2352x1568px, 45° FOV:
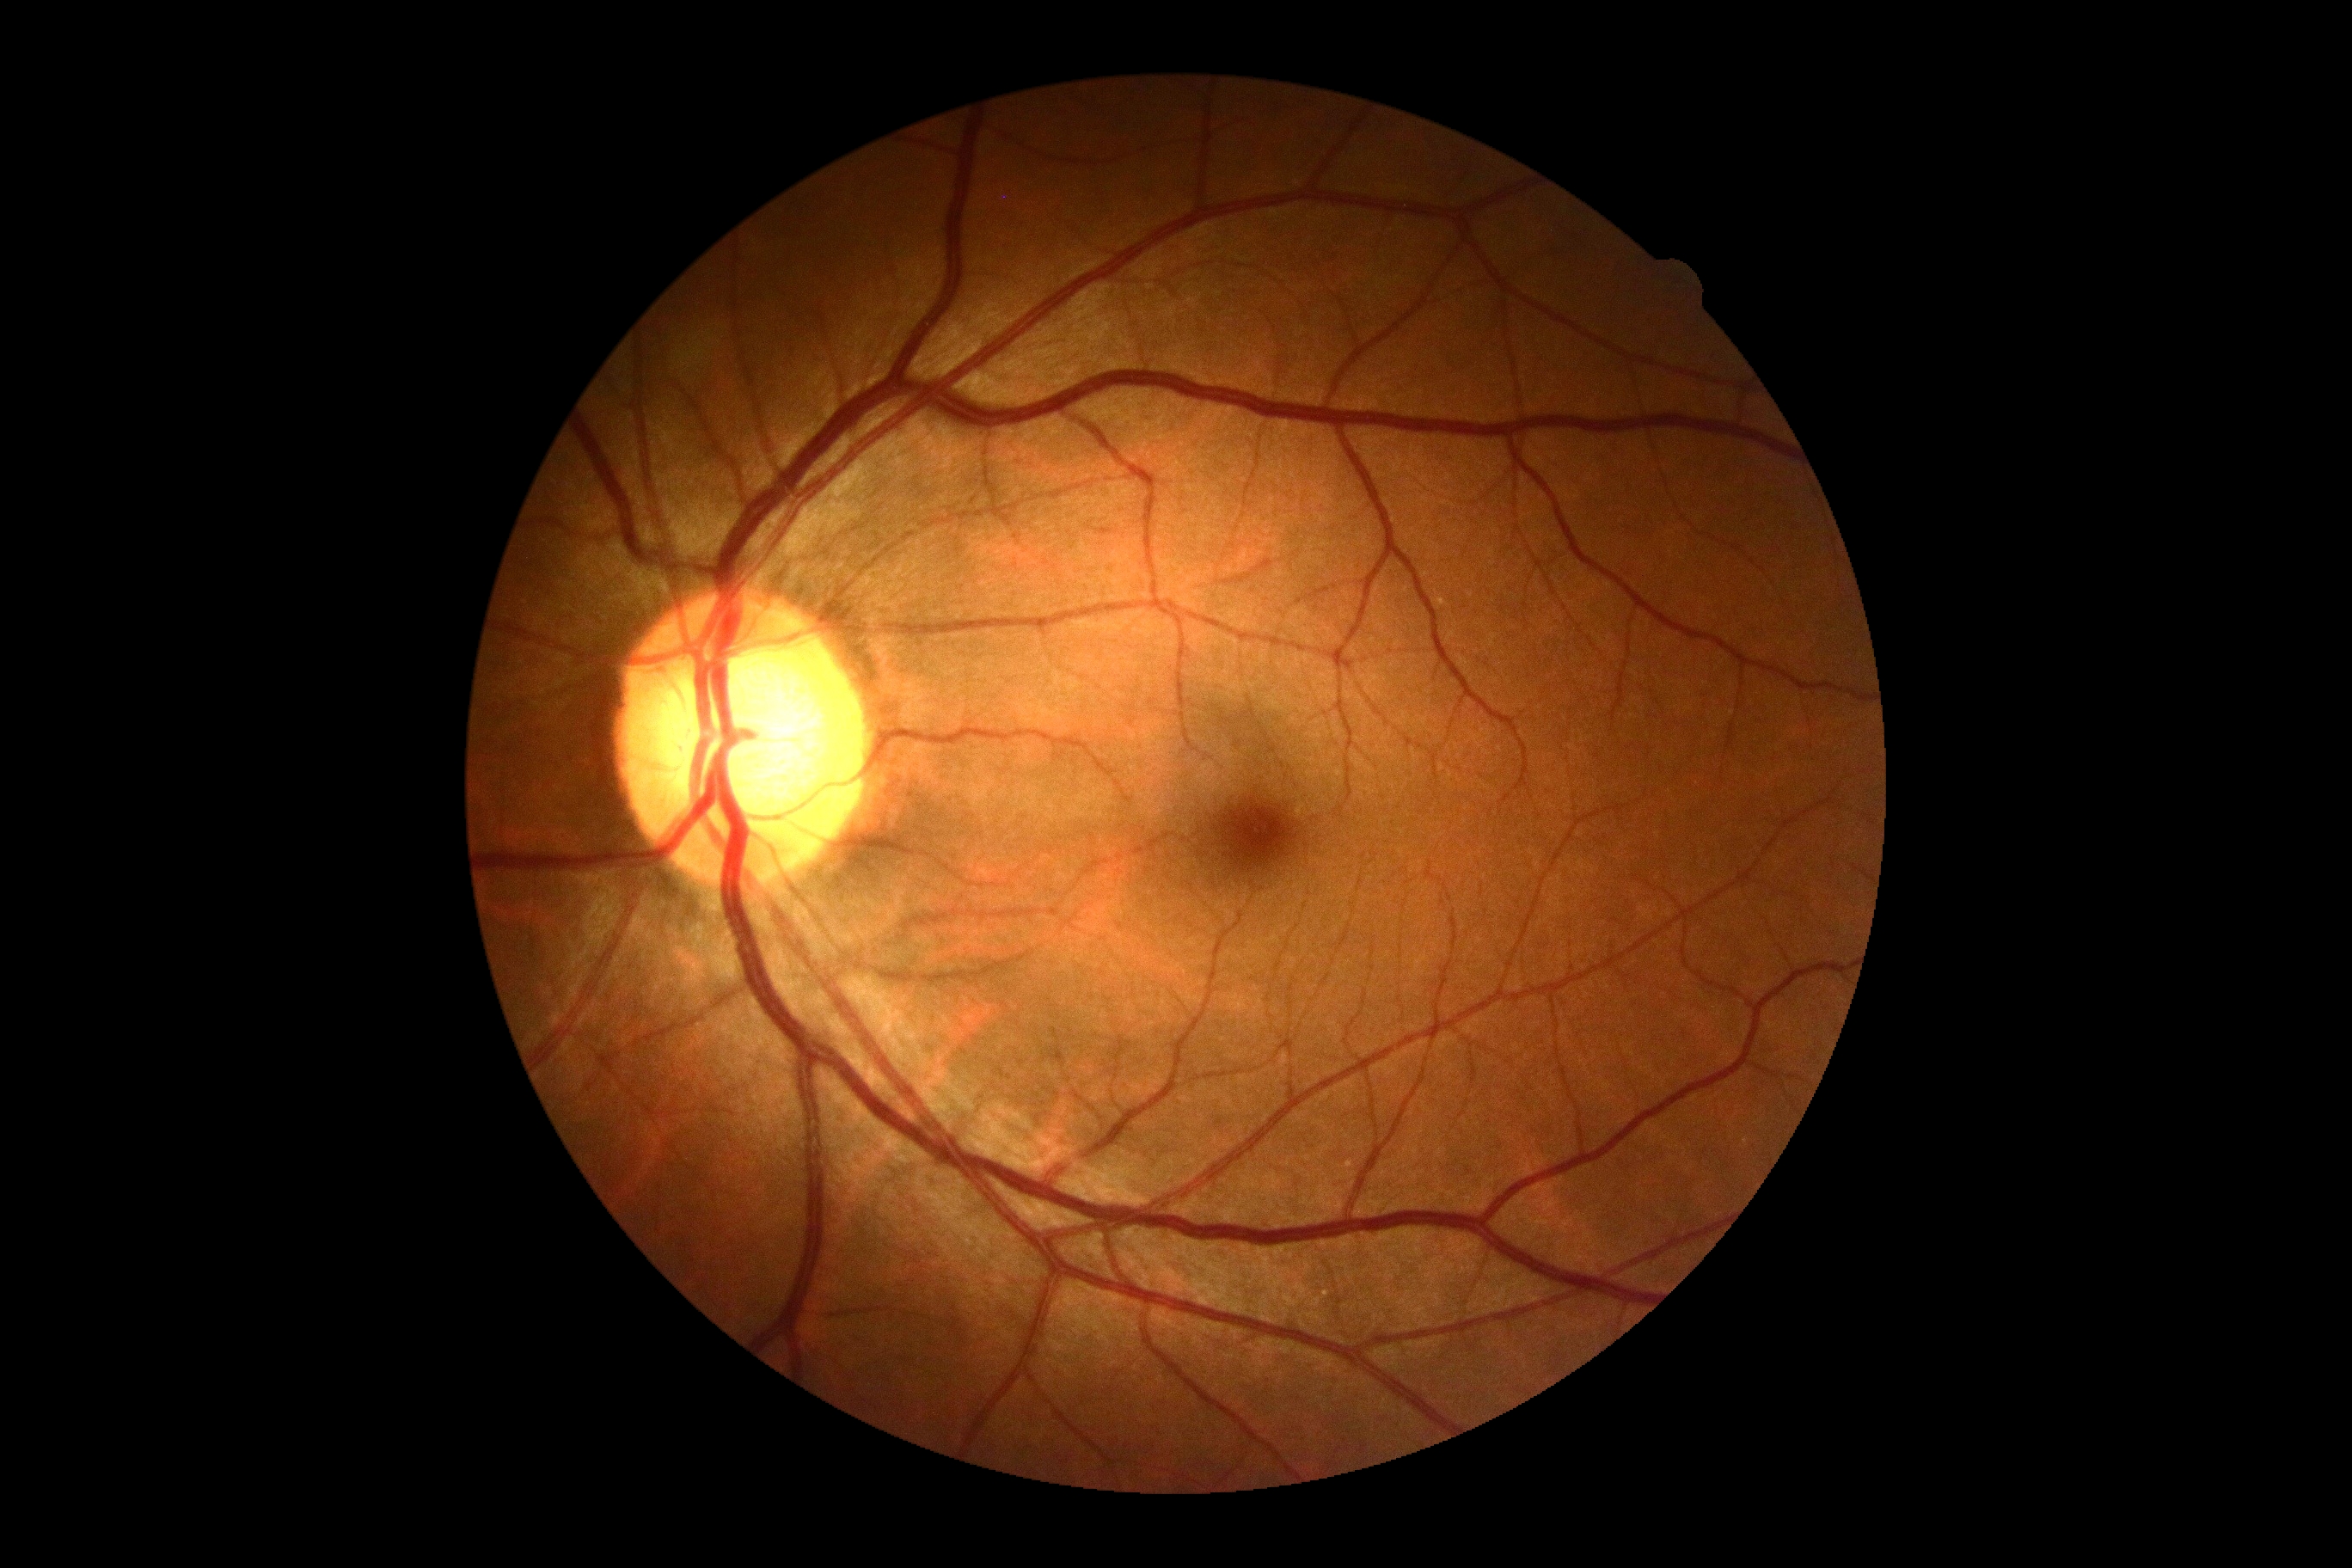

Diabetic retinopathy severity: 0.